Wide-field fundus photograph from neonatal ROP screening; 640 x 480 pixels
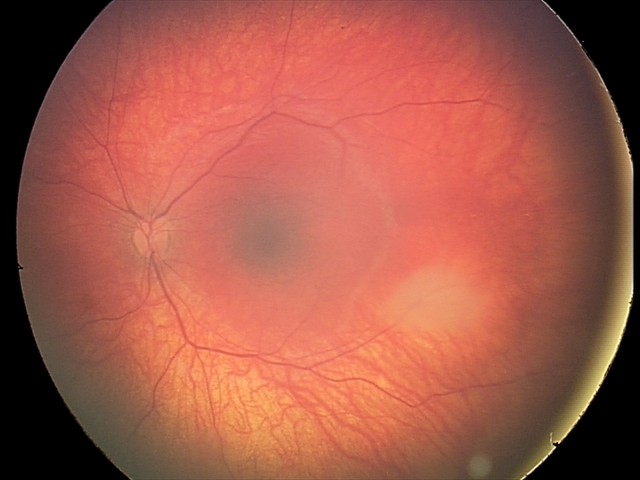
Diagnosis: retinal astrocytic hamartoma